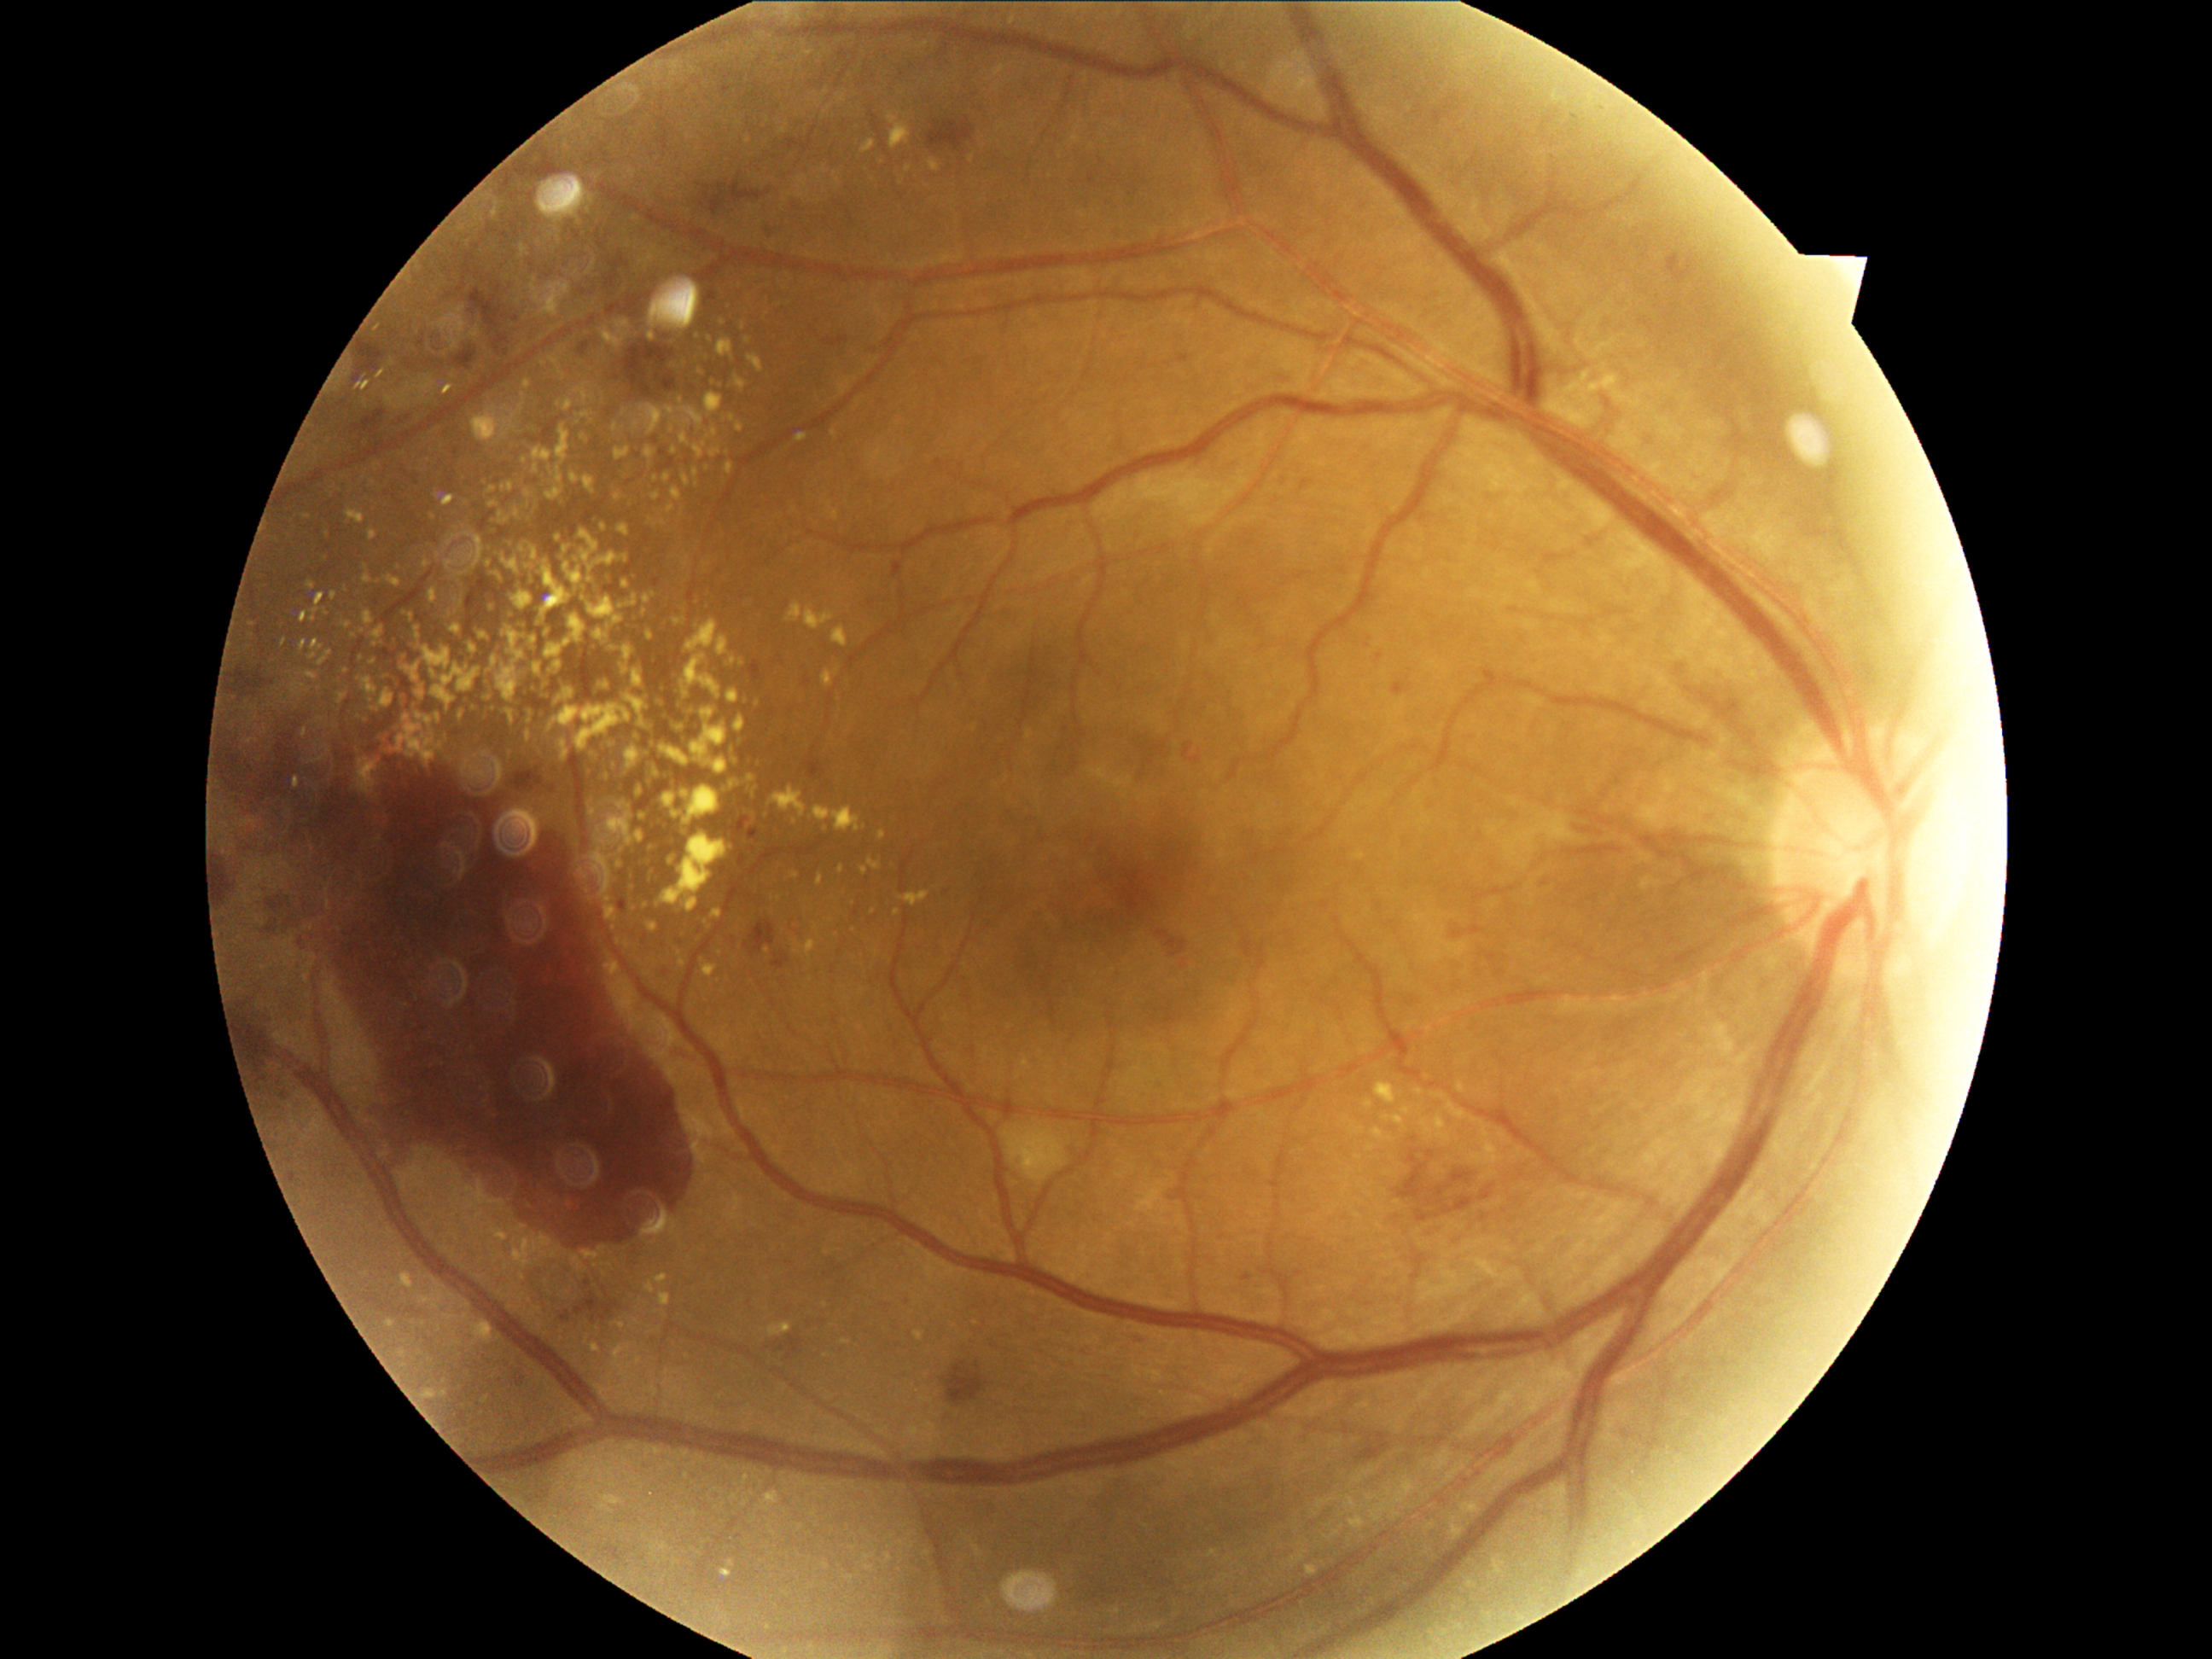 Diabetic retinopathy grade is 4. Hard exudates are present, including at region(731, 759, 740, 767), region(697, 370, 702, 378), region(684, 407, 704, 429), region(716, 636, 730, 656), region(402, 612, 405, 620), region(583, 477, 595, 494), region(530, 547, 538, 561), region(629, 885, 637, 895), region(704, 965, 716, 977), region(648, 1284, 655, 1293), region(817, 876, 824, 887), region(813, 806, 859, 832). Small hard exudates approximately at x=323 y=559, x=705 y=608, x=742 y=665, x=591 y=755, x=599 y=830, x=753 y=820, x=638 y=739.